Image size 848x848
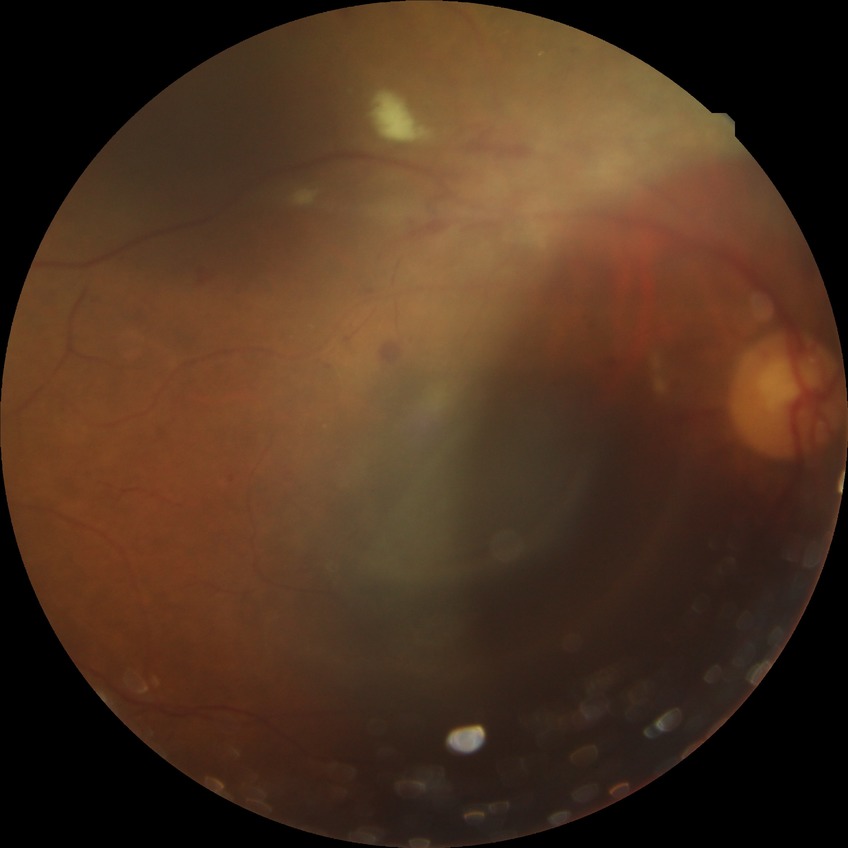 Diabetic retinopathy (DR) is PDR (proliferative diabetic retinopathy).